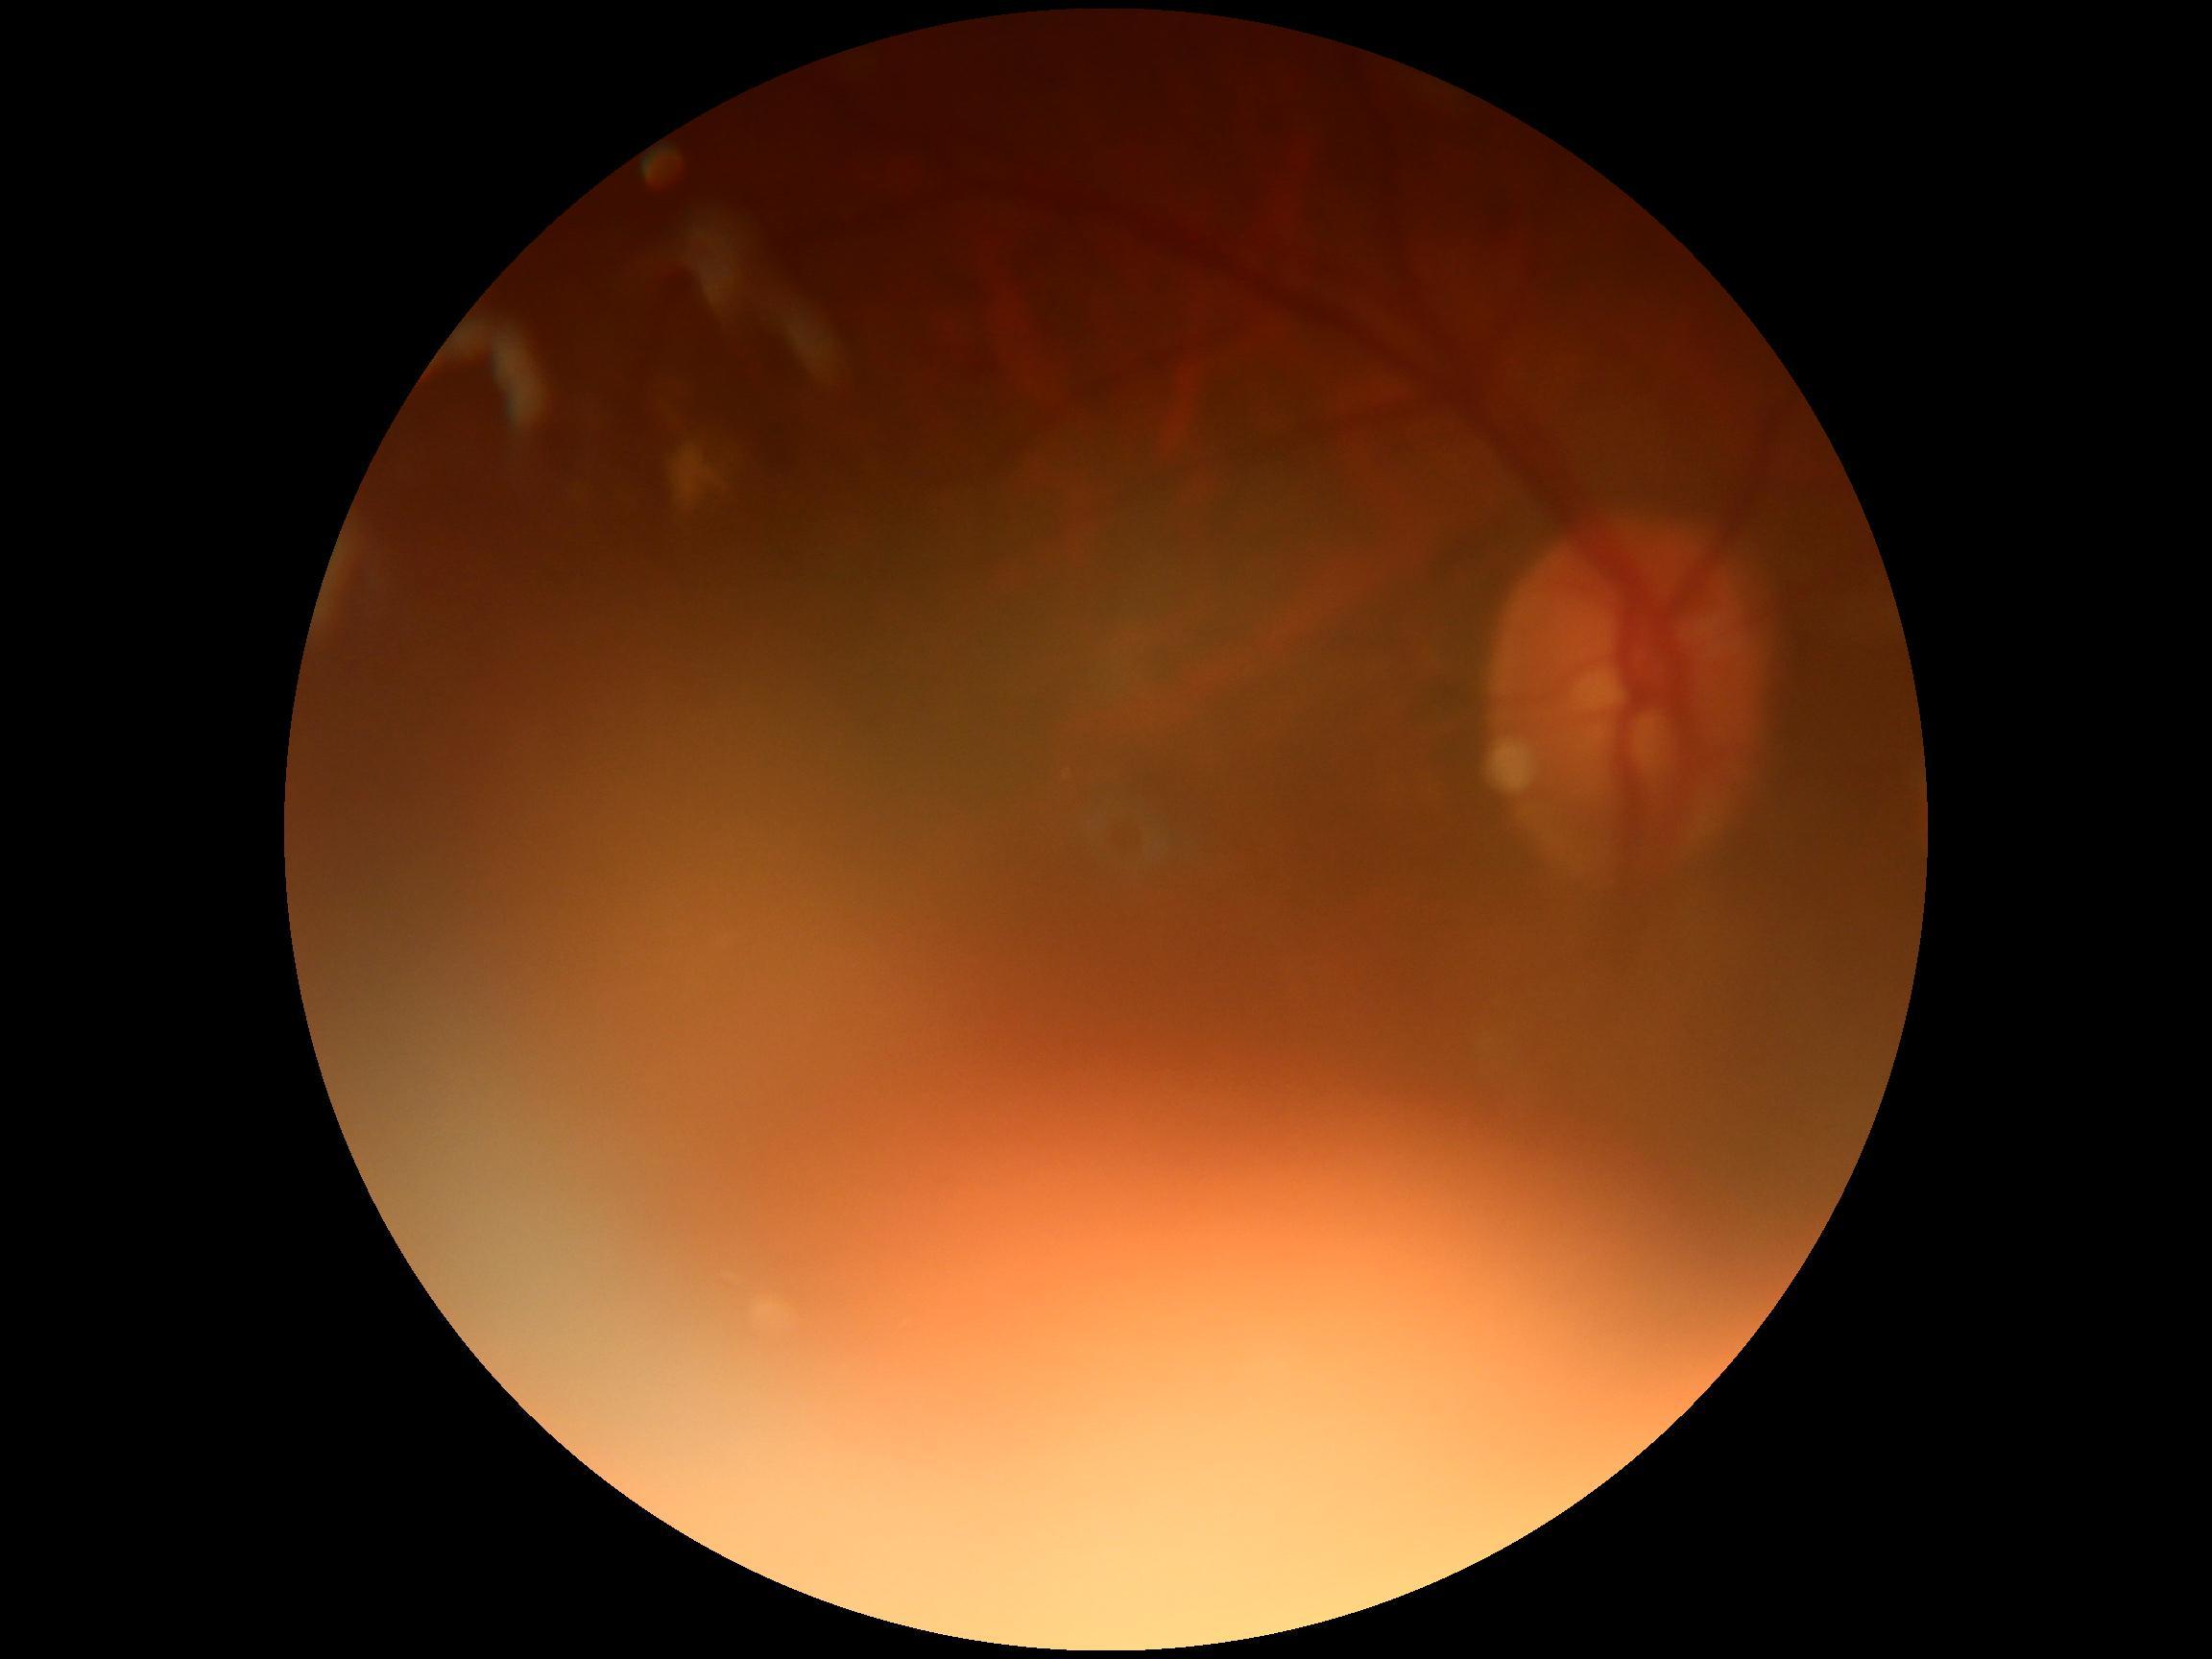
diabetic retinopathy (DR)@ungradable; image quality@insufficient.